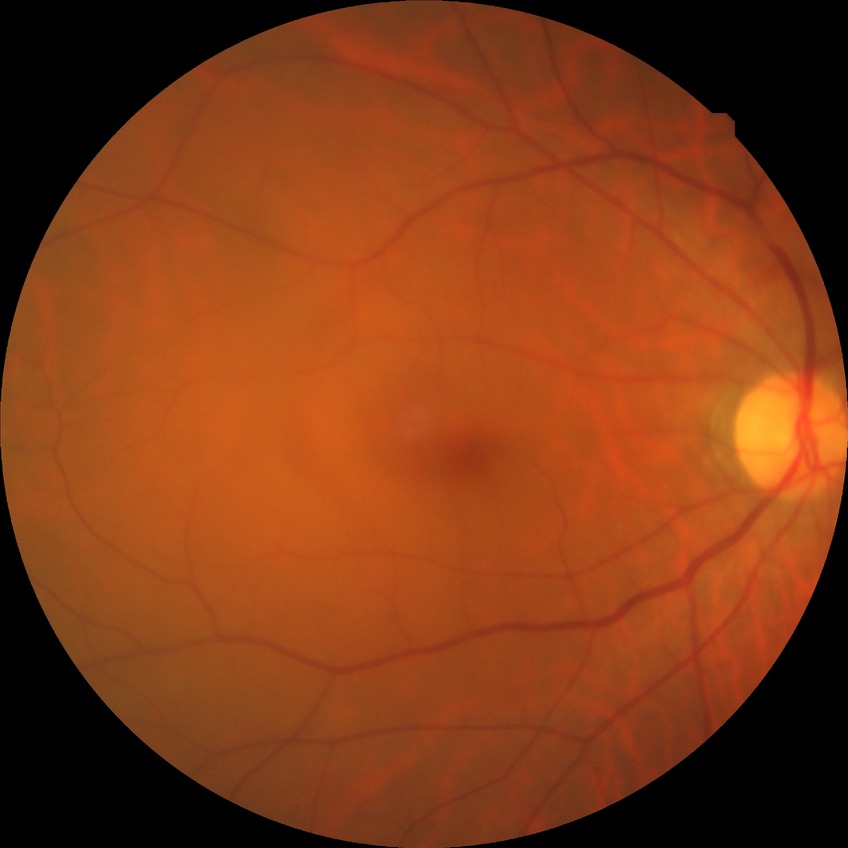 Davis grading: no diabetic retinopathy.